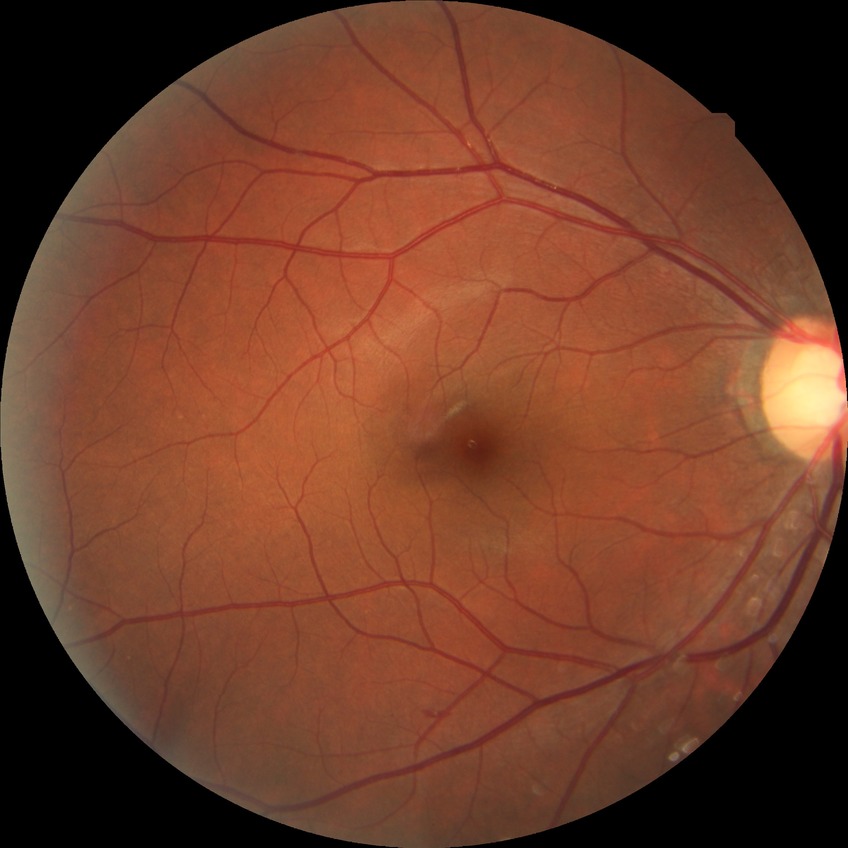 retinopathy stage: no diabetic retinopathy.